Fundus photo; acquired with a NIDEK AFC-230; 848x848px; nonmydriatic fundus photograph
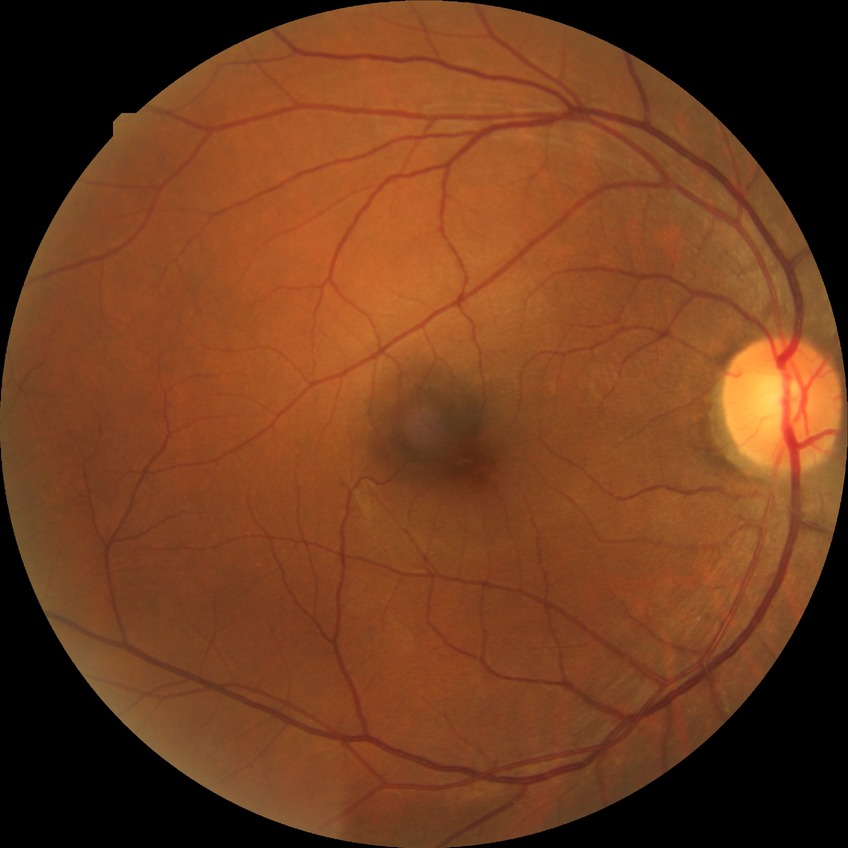
Davis DR grade is NDR.